FOV: 45 degrees, modified Davis classification: 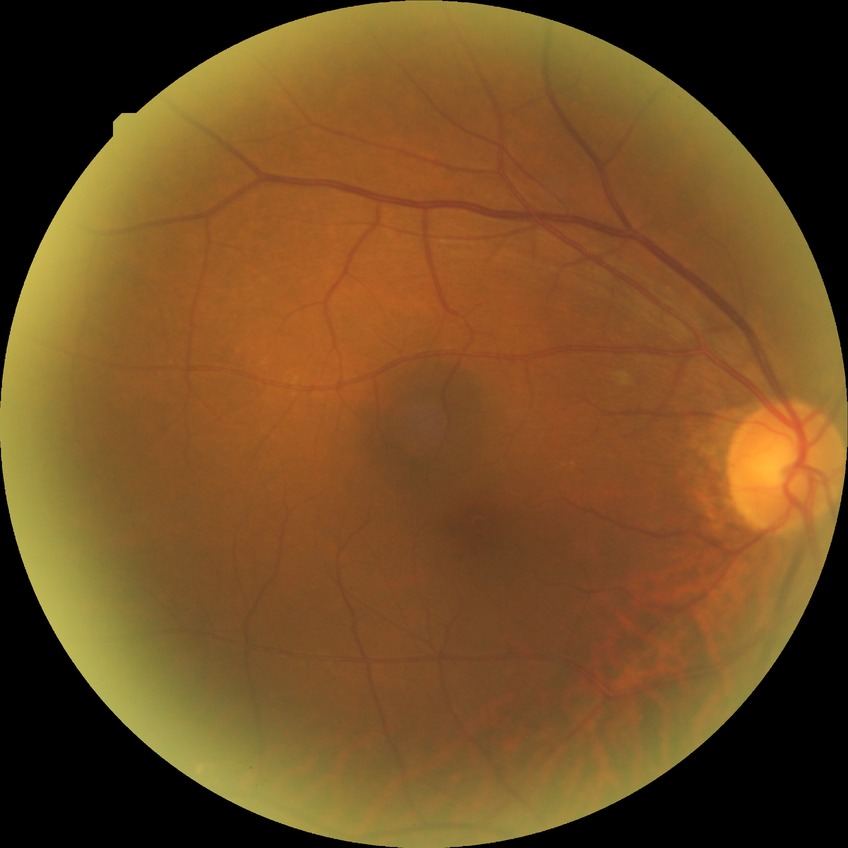 {
  "davis_grade": "no diabetic retinopathy"
}